2352 x 1568 pixels
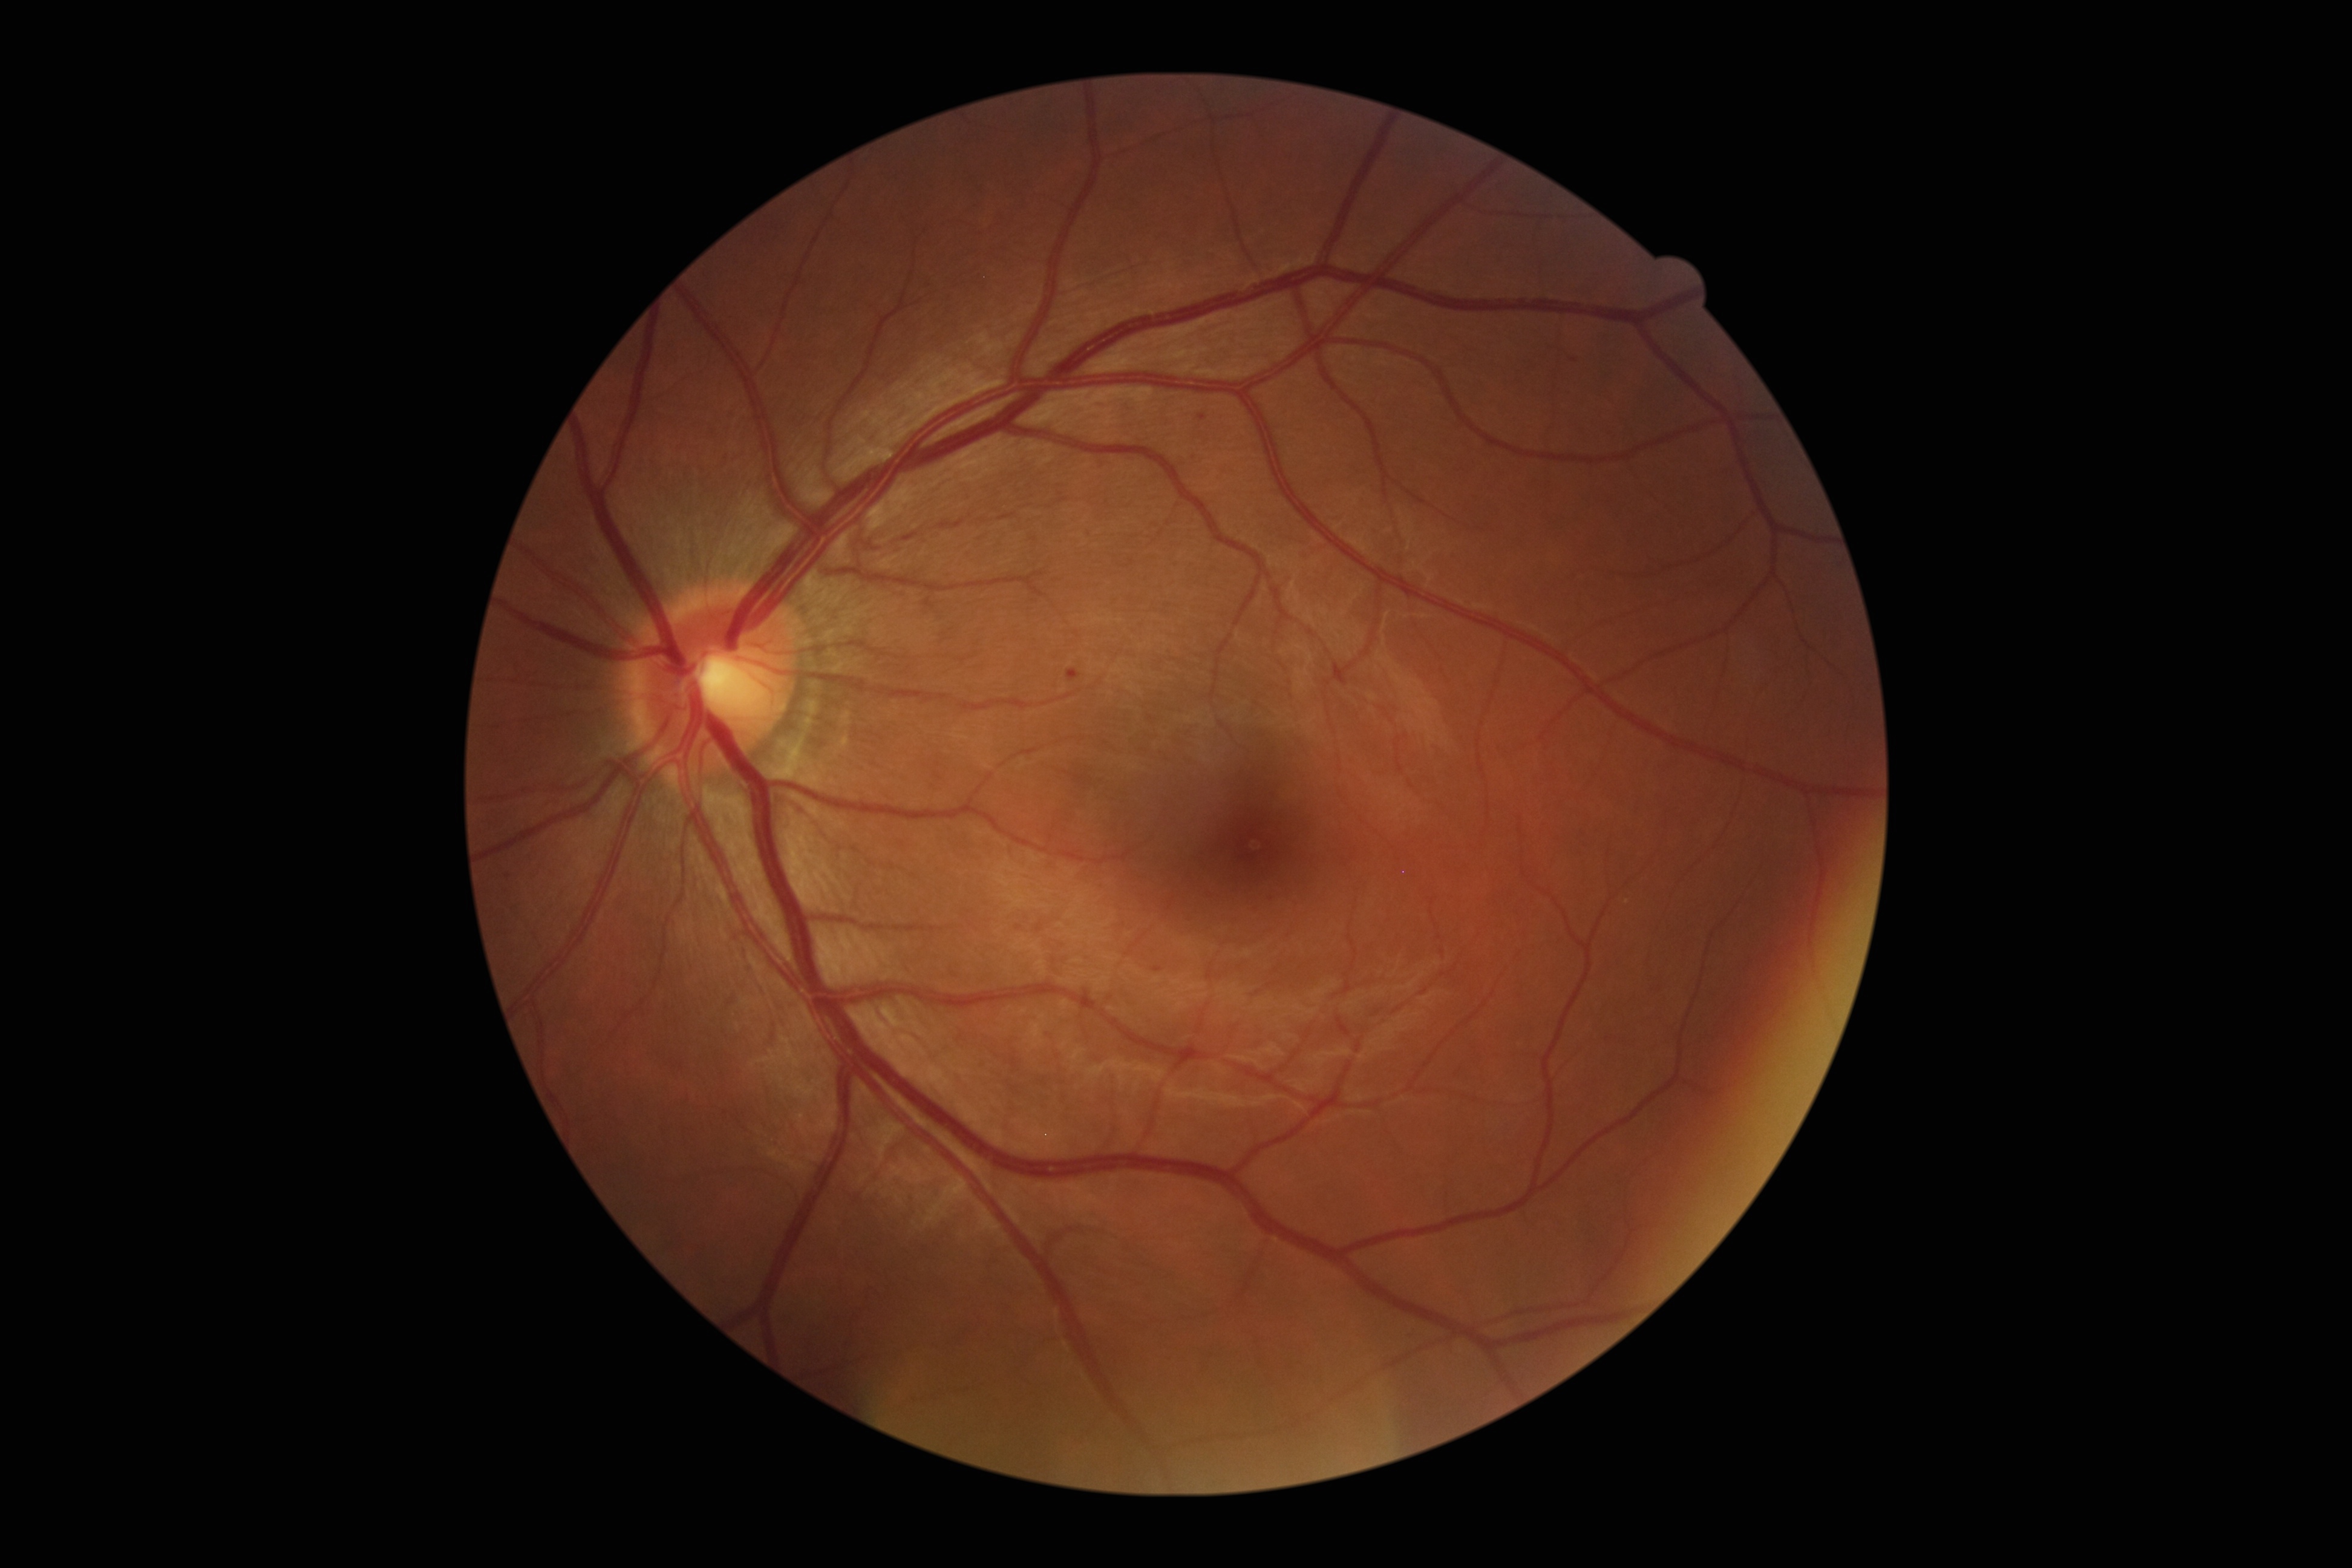

Diabetic retinopathy (DR) is 1 — presence of microaneurysms only
hard exudates (EXs): none detected
microaneurysms (MAs): <box>1154,967,1163,973</box>
Smaller MAs around [x=1574, y=360]; [x=1203, y=419]
hemorrhages (HEs): <box>1068,668,1081,683</box>
soft exudates (SEs): none detected